45° field of view · modified Davis grading:
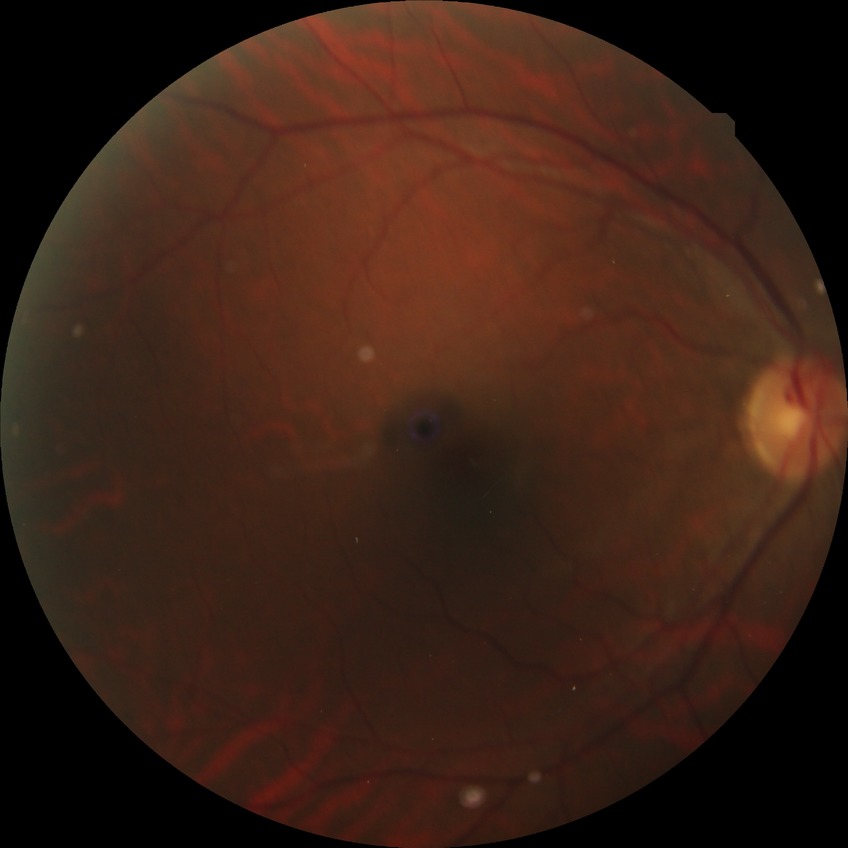 Diabetic retinopathy stage is no diabetic retinopathy.